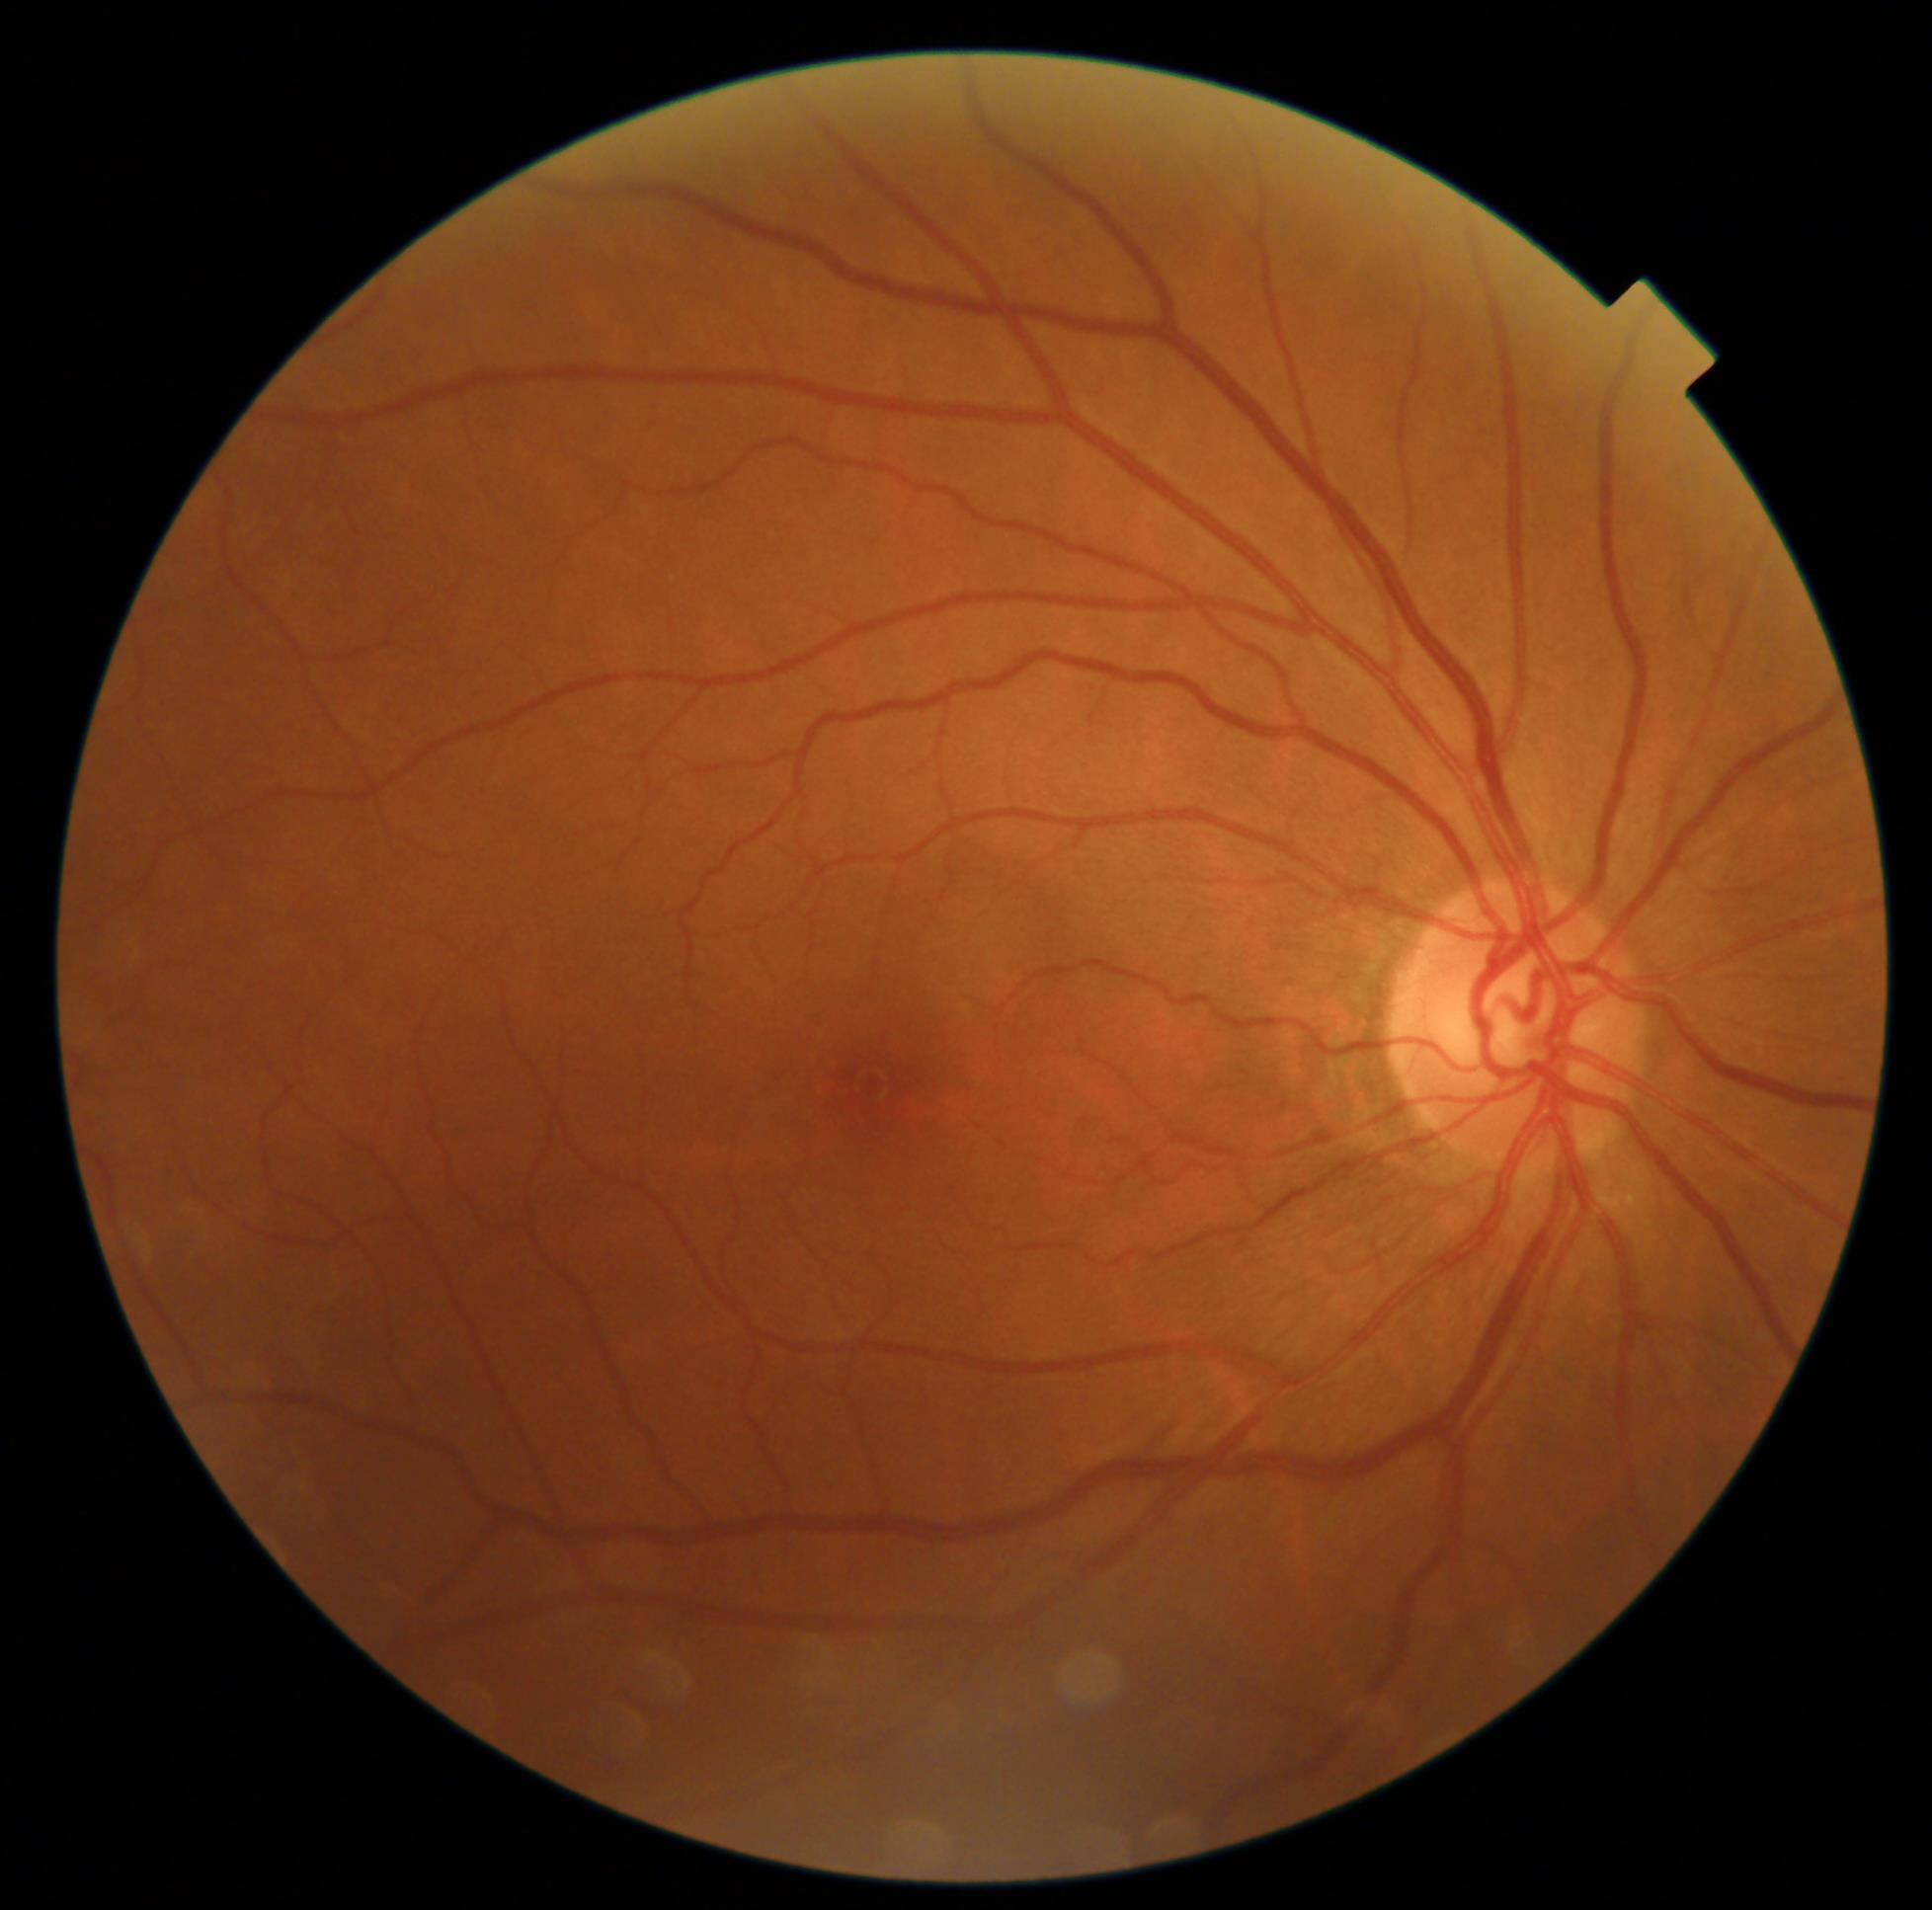 DR: 1 — presence of microaneurysms only.